Color fundus photograph centered on the optic disc: 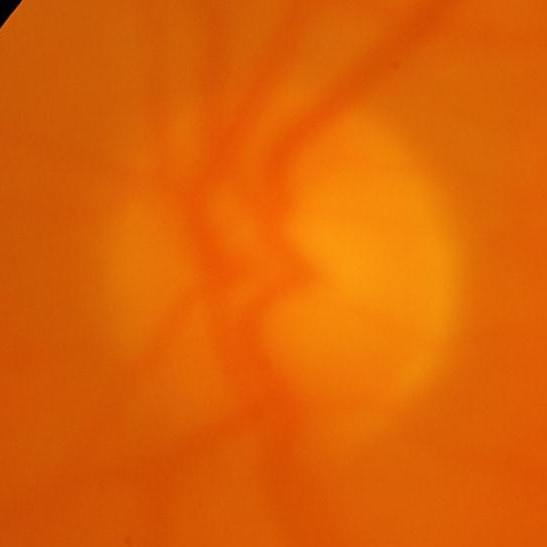
Q: Is glaucoma present?
A: Glaucomatous optic neuropathy.